2352 by 1568 pixels:
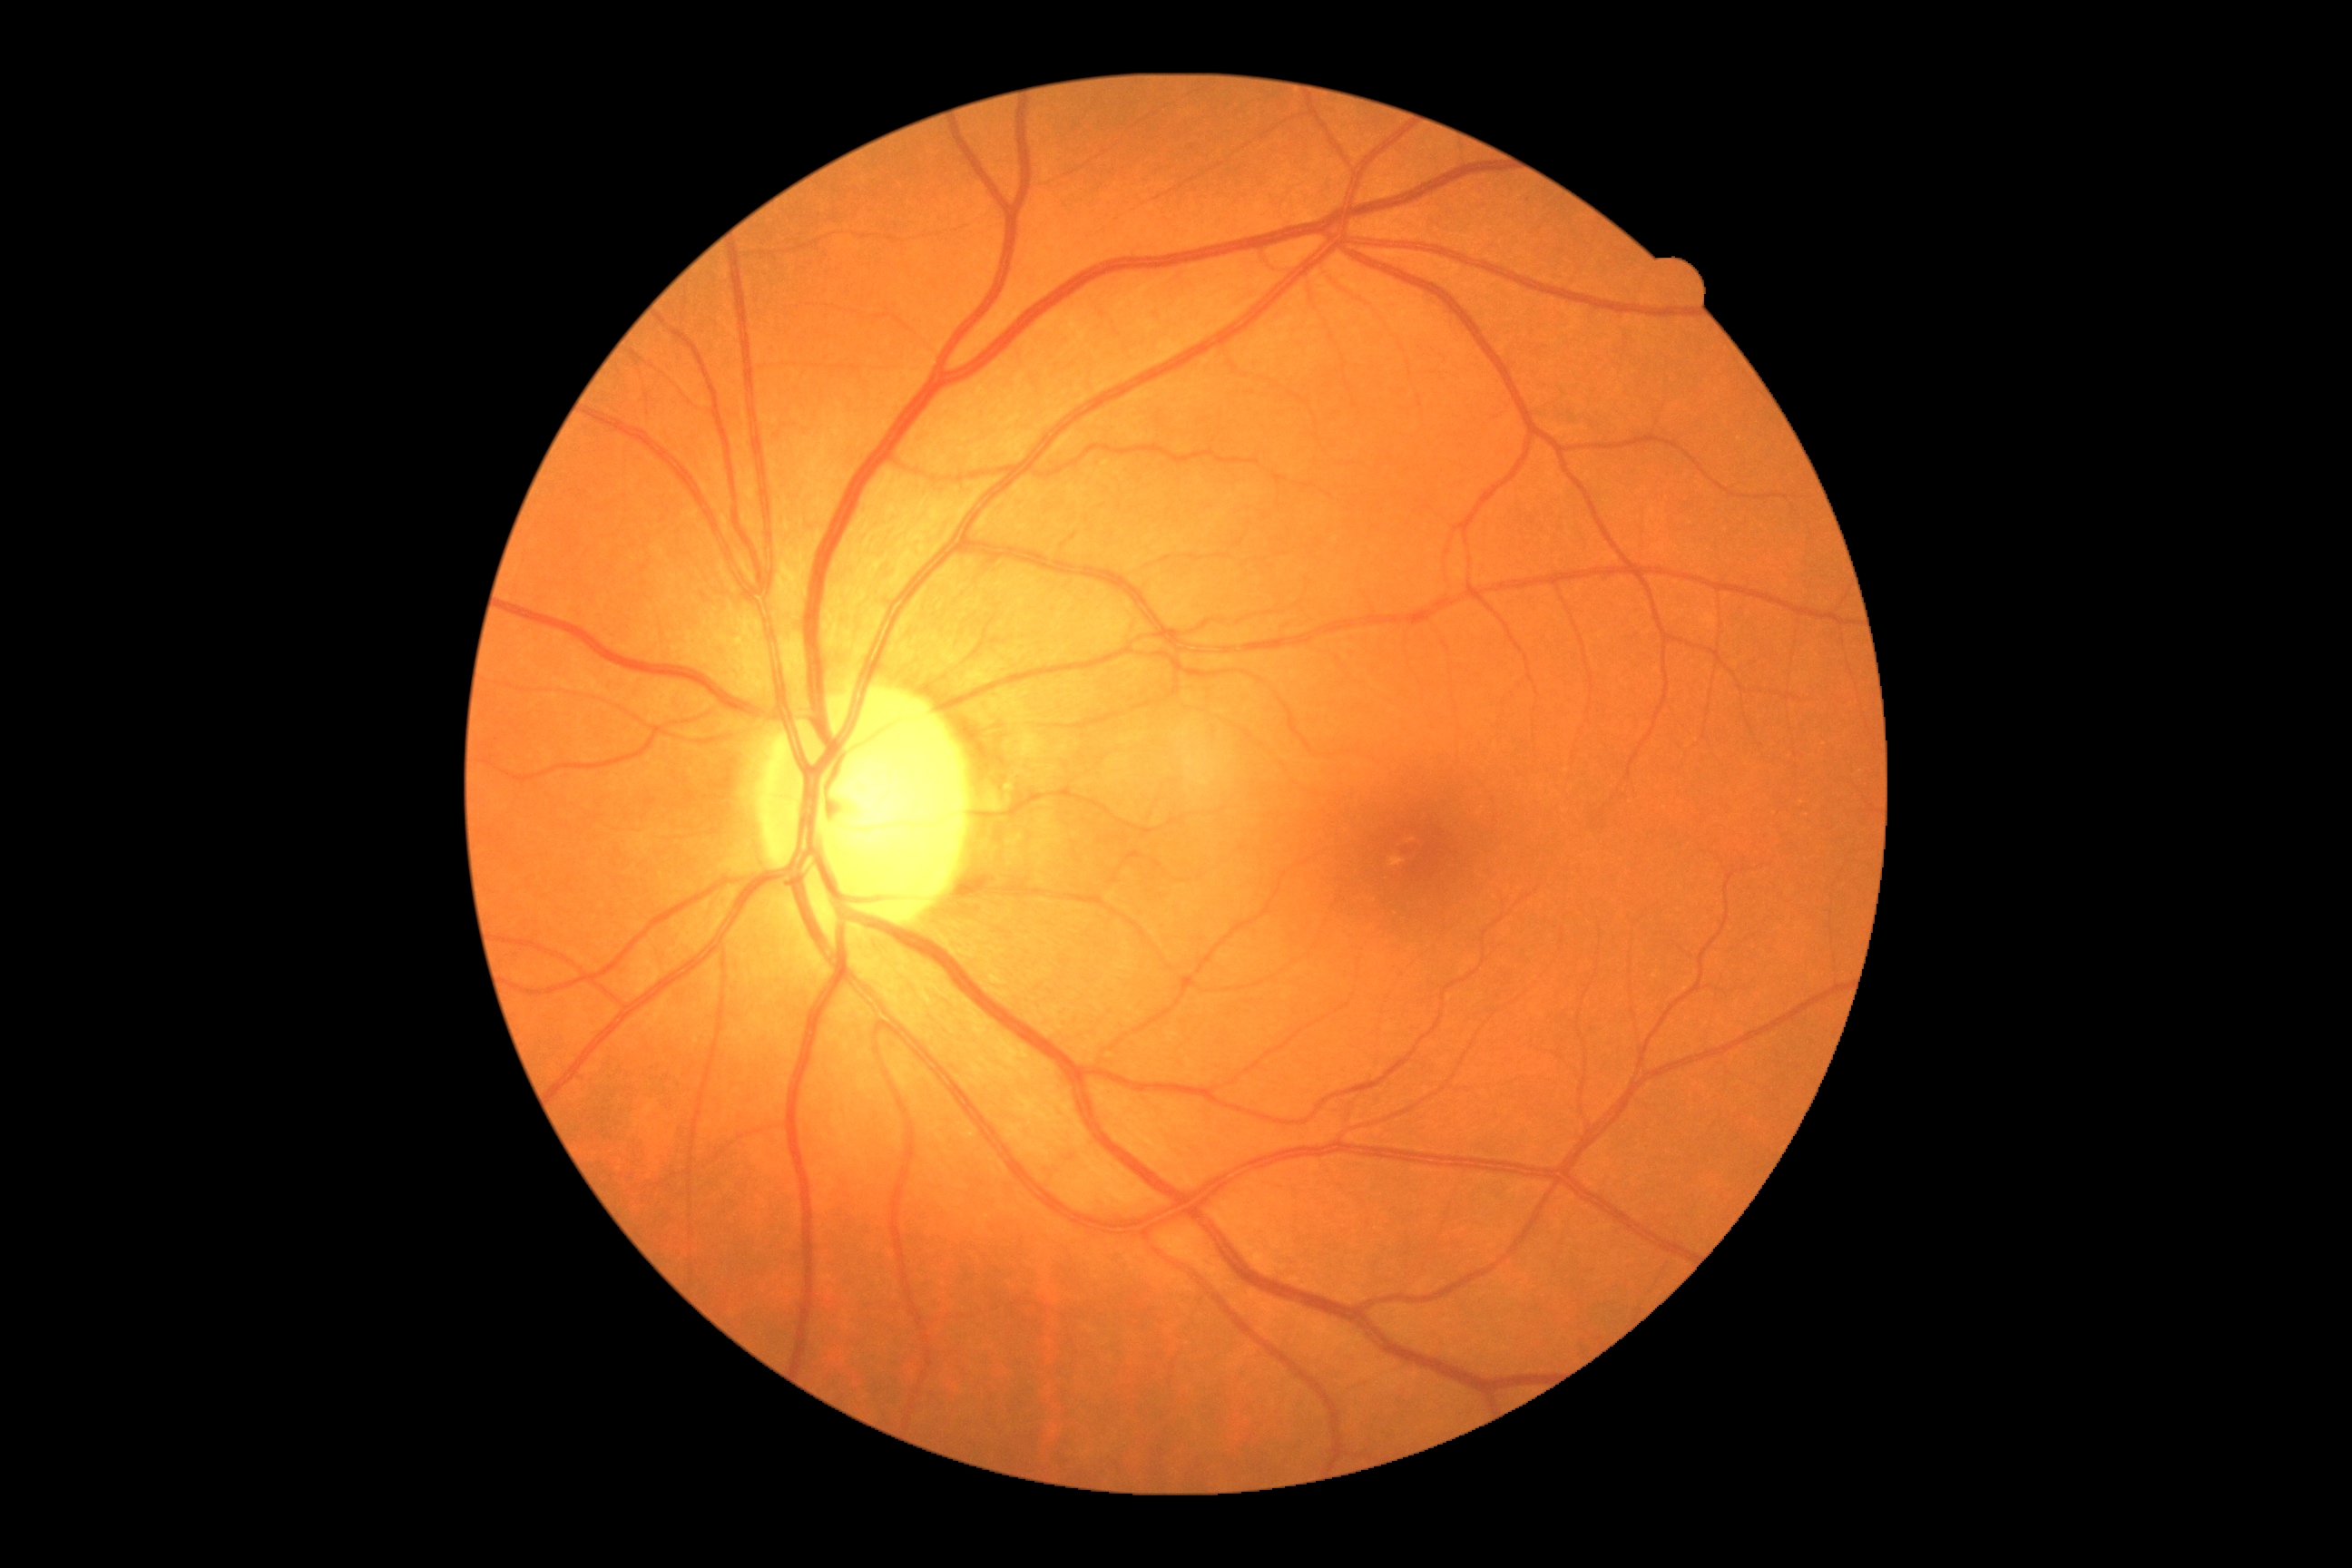

• DR stage: no apparent retinopathy (grade 0)